Wide-field fundus image from infant ROP screening
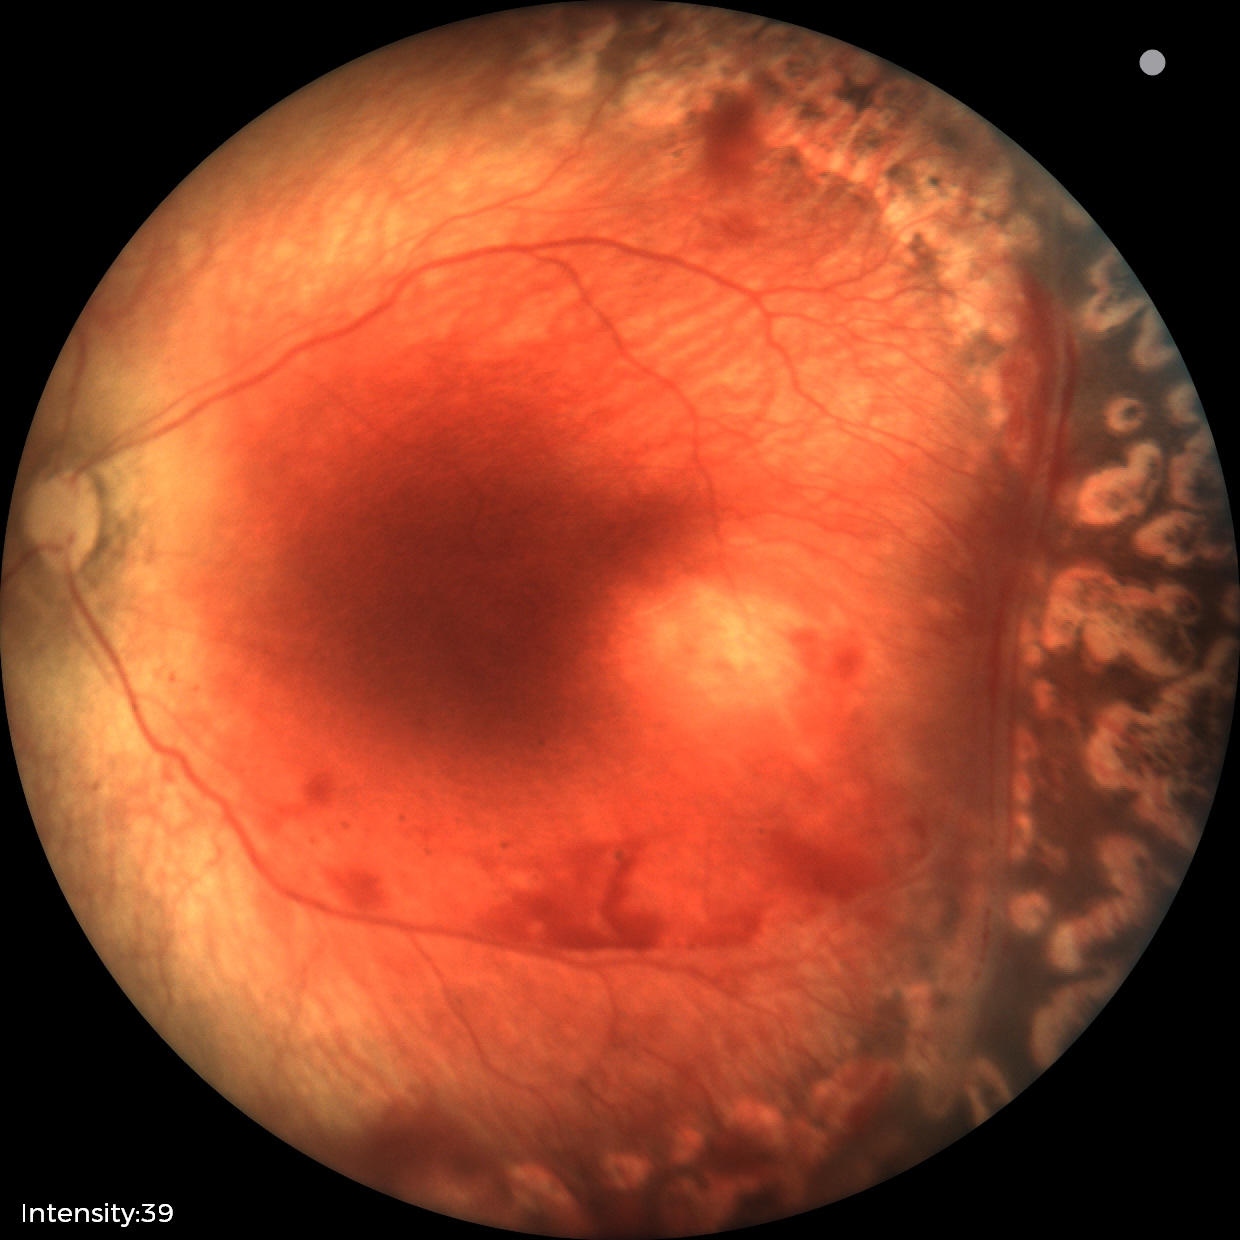

Examination diagnosed as status post retinopathy of prematurity — retinal appearance after treated retinopathy of prematurity.
Plus disease absent.